Nonmydriatic — 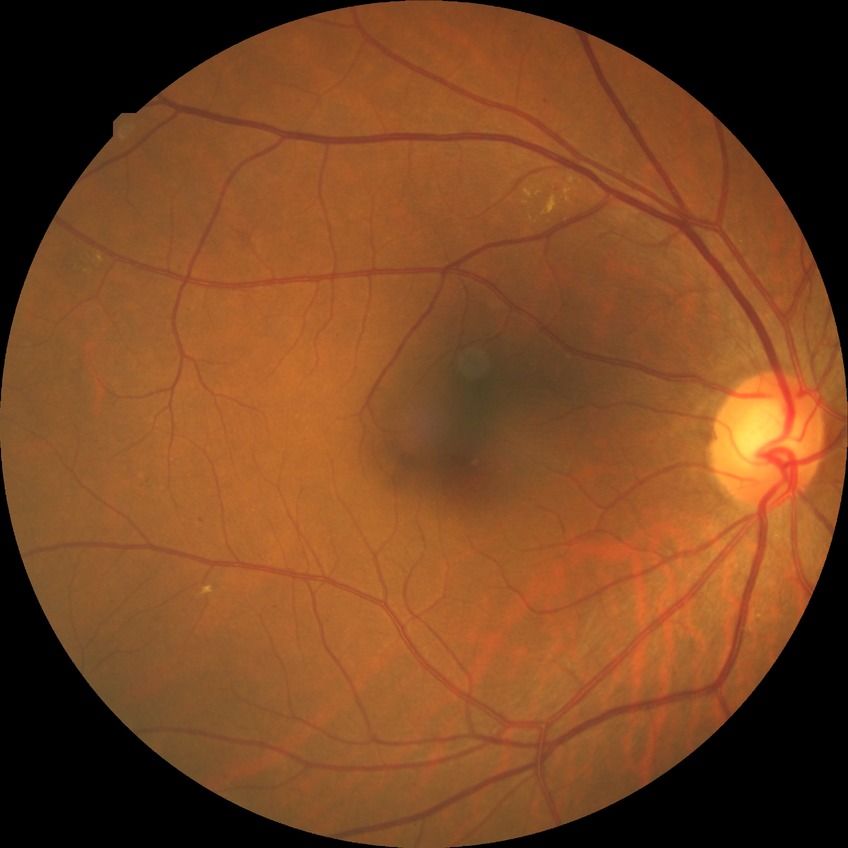 davis_grade: simple diabetic retinopathy